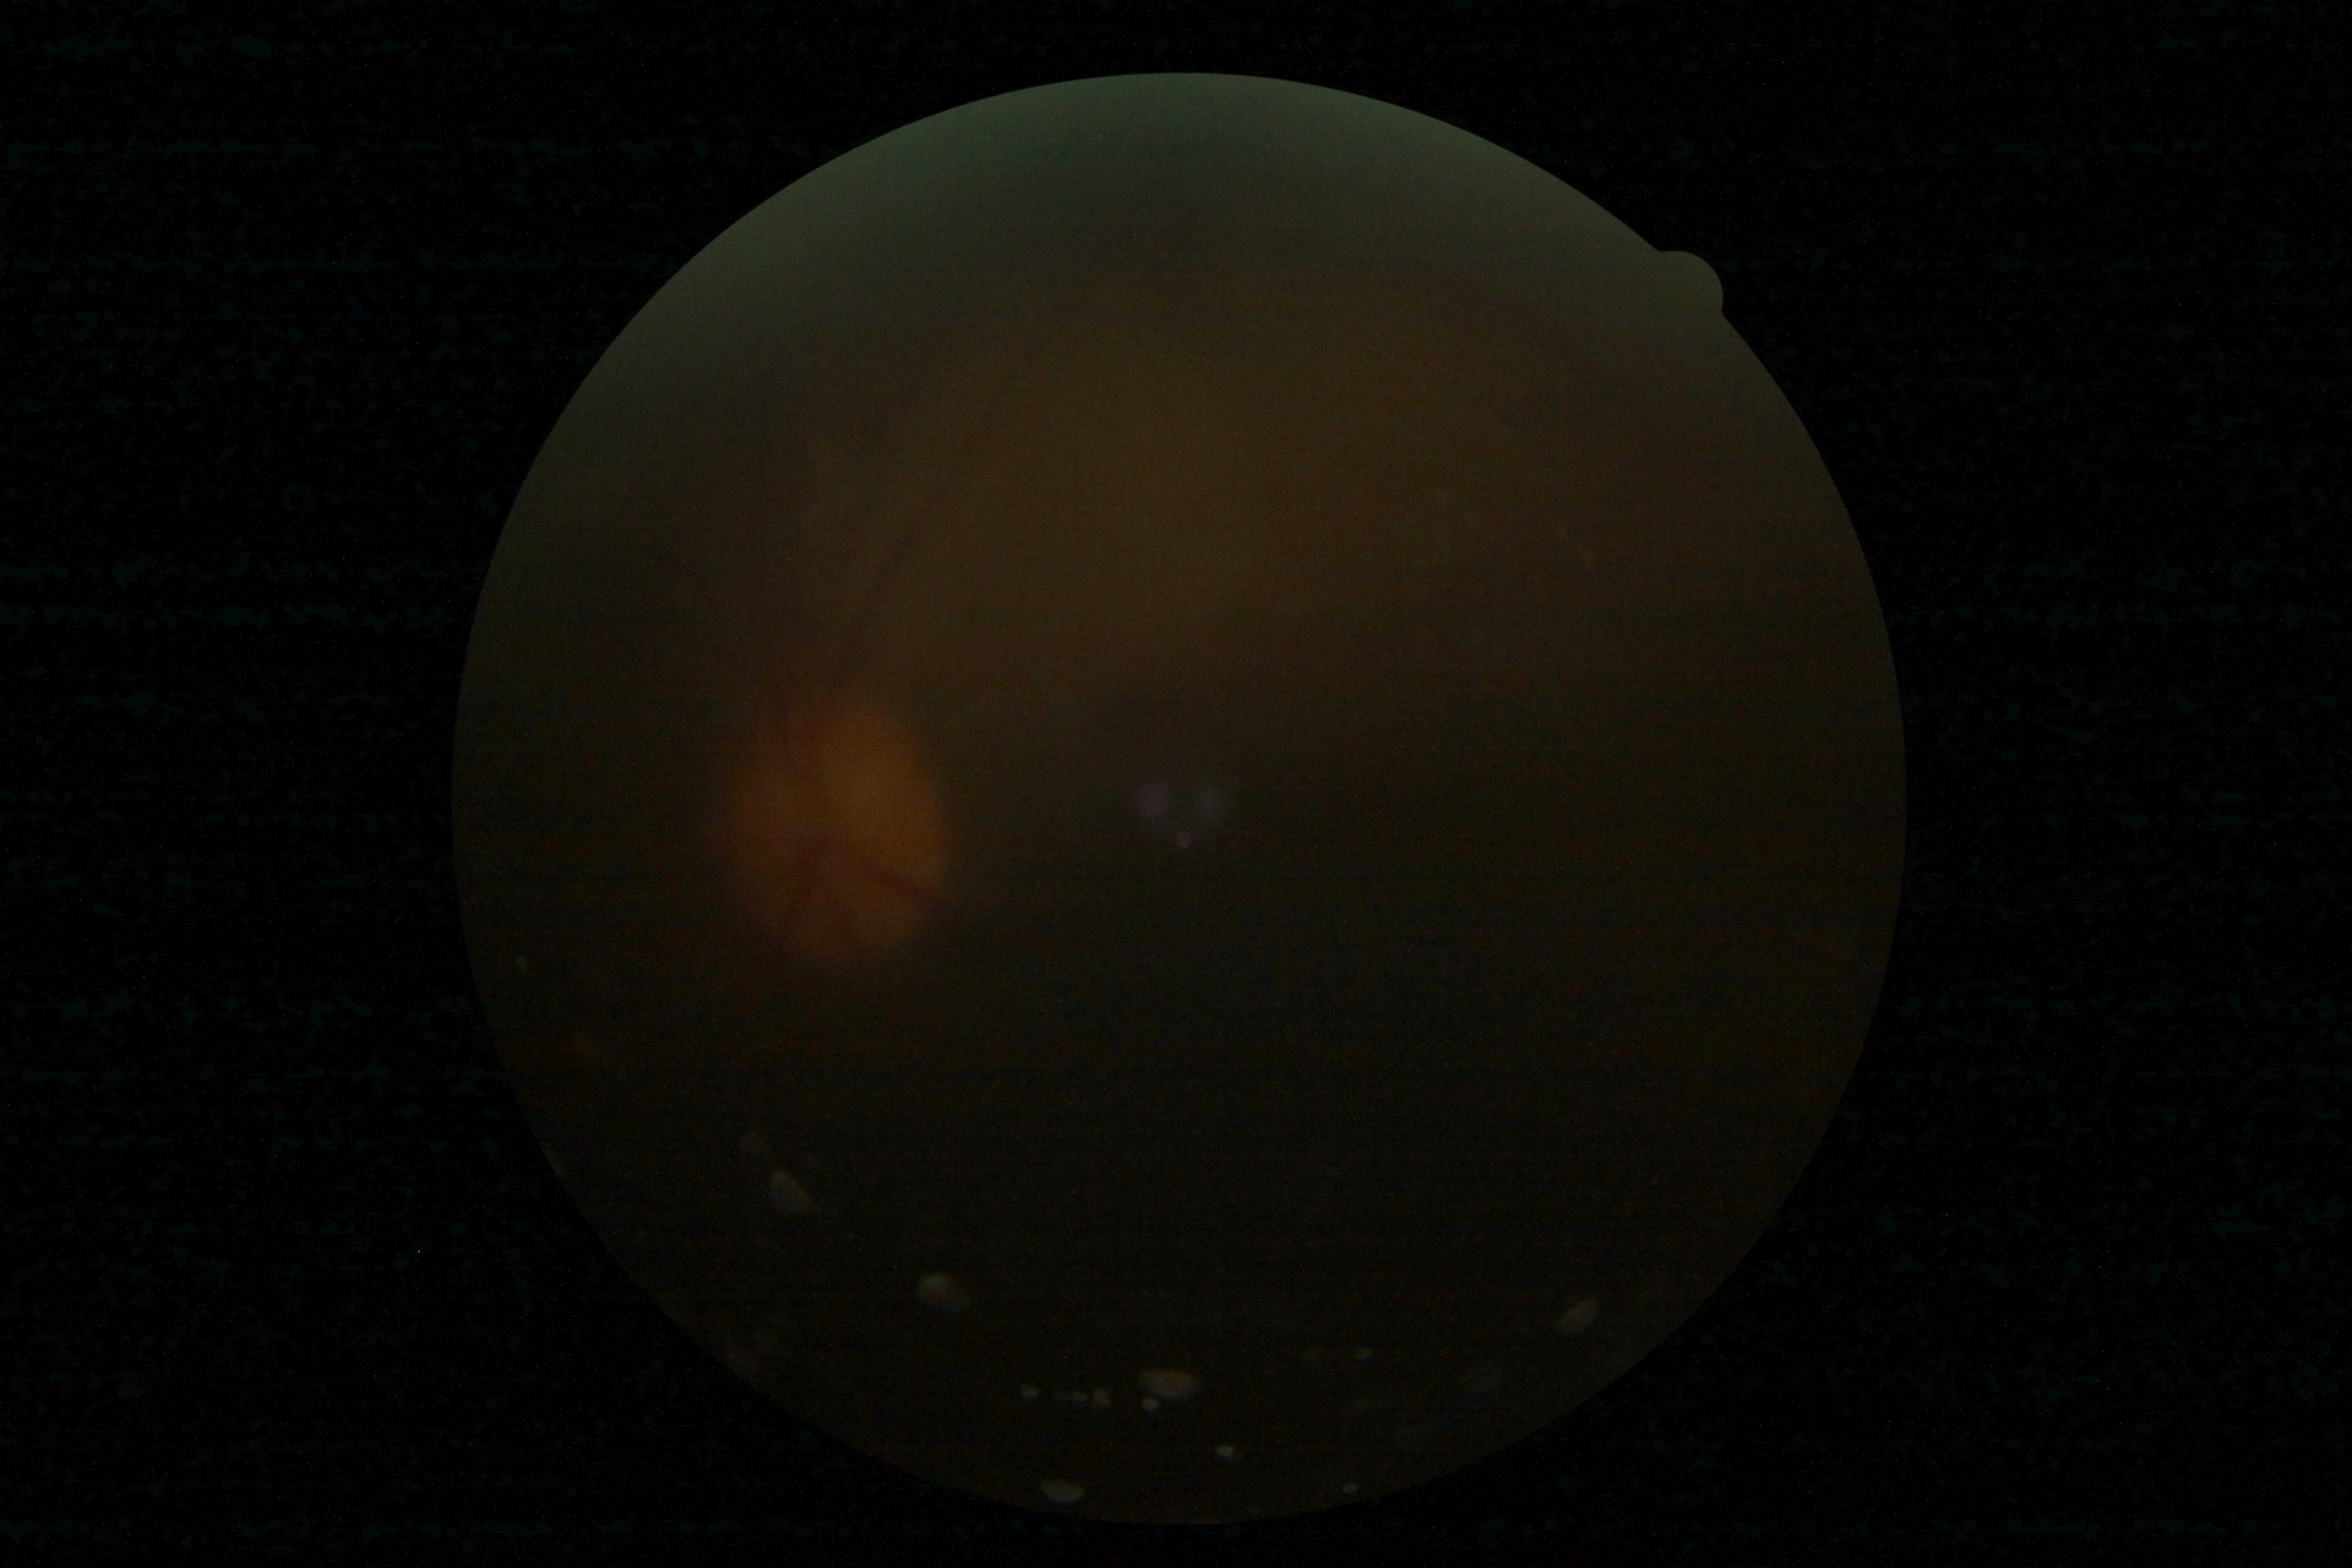
Findings:
– diabetic retinopathy (DR) — ungradable